Wide-field fundus photograph of an infant
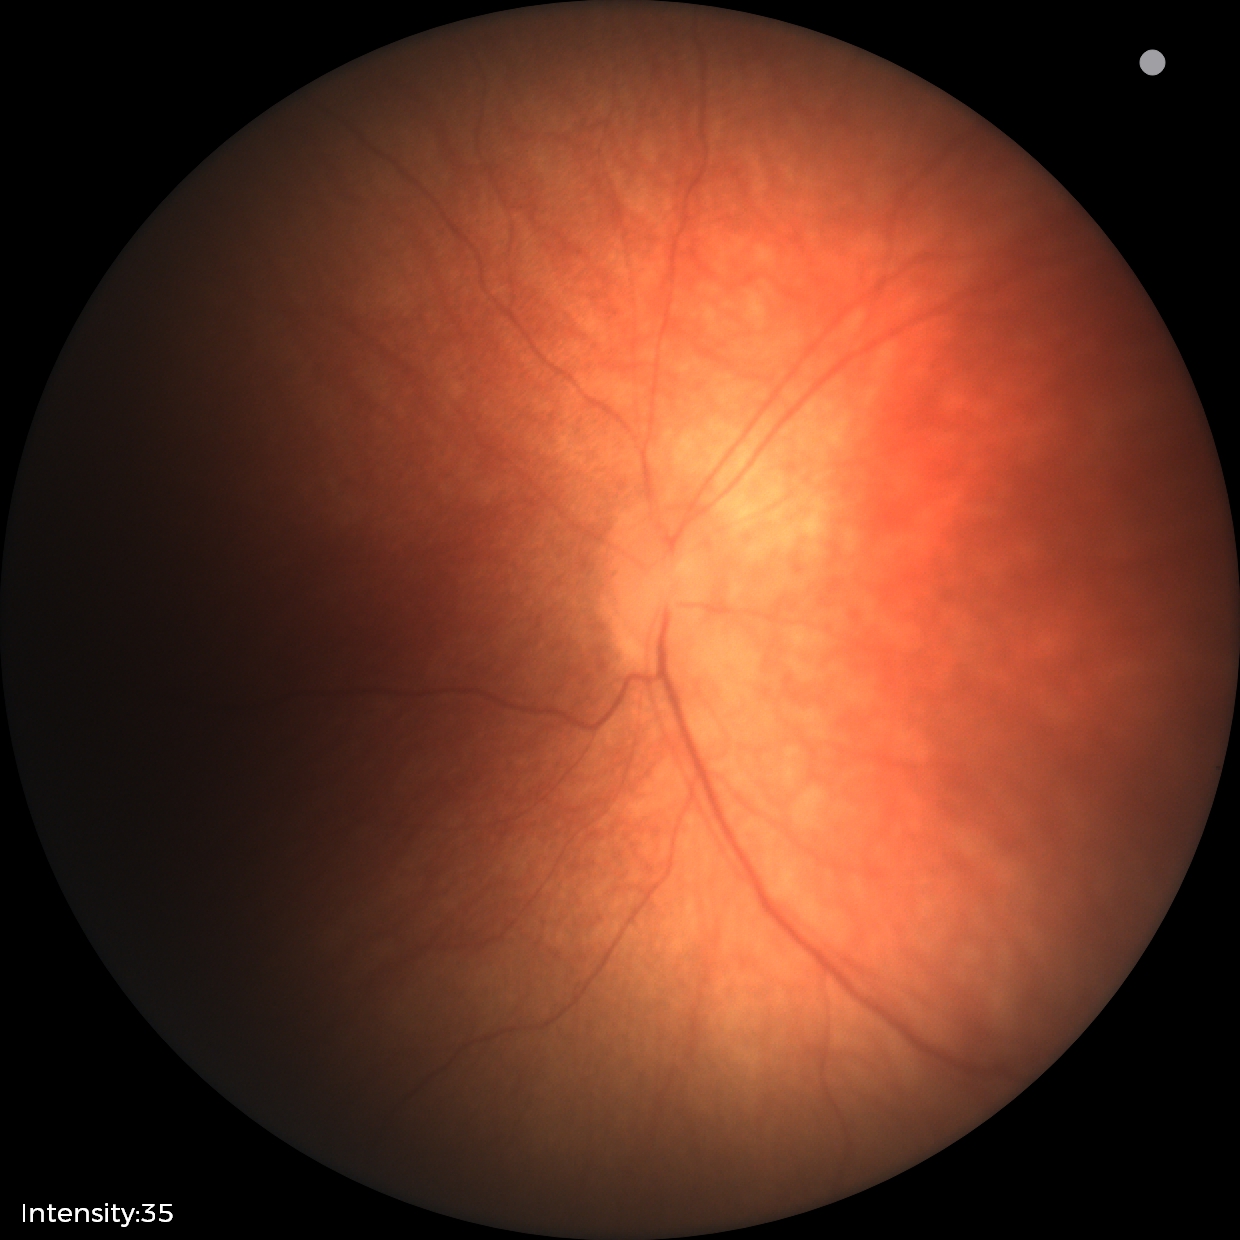 Impression = no pathology identified.